1932 x 1932 pixels, FOV: 45 degrees
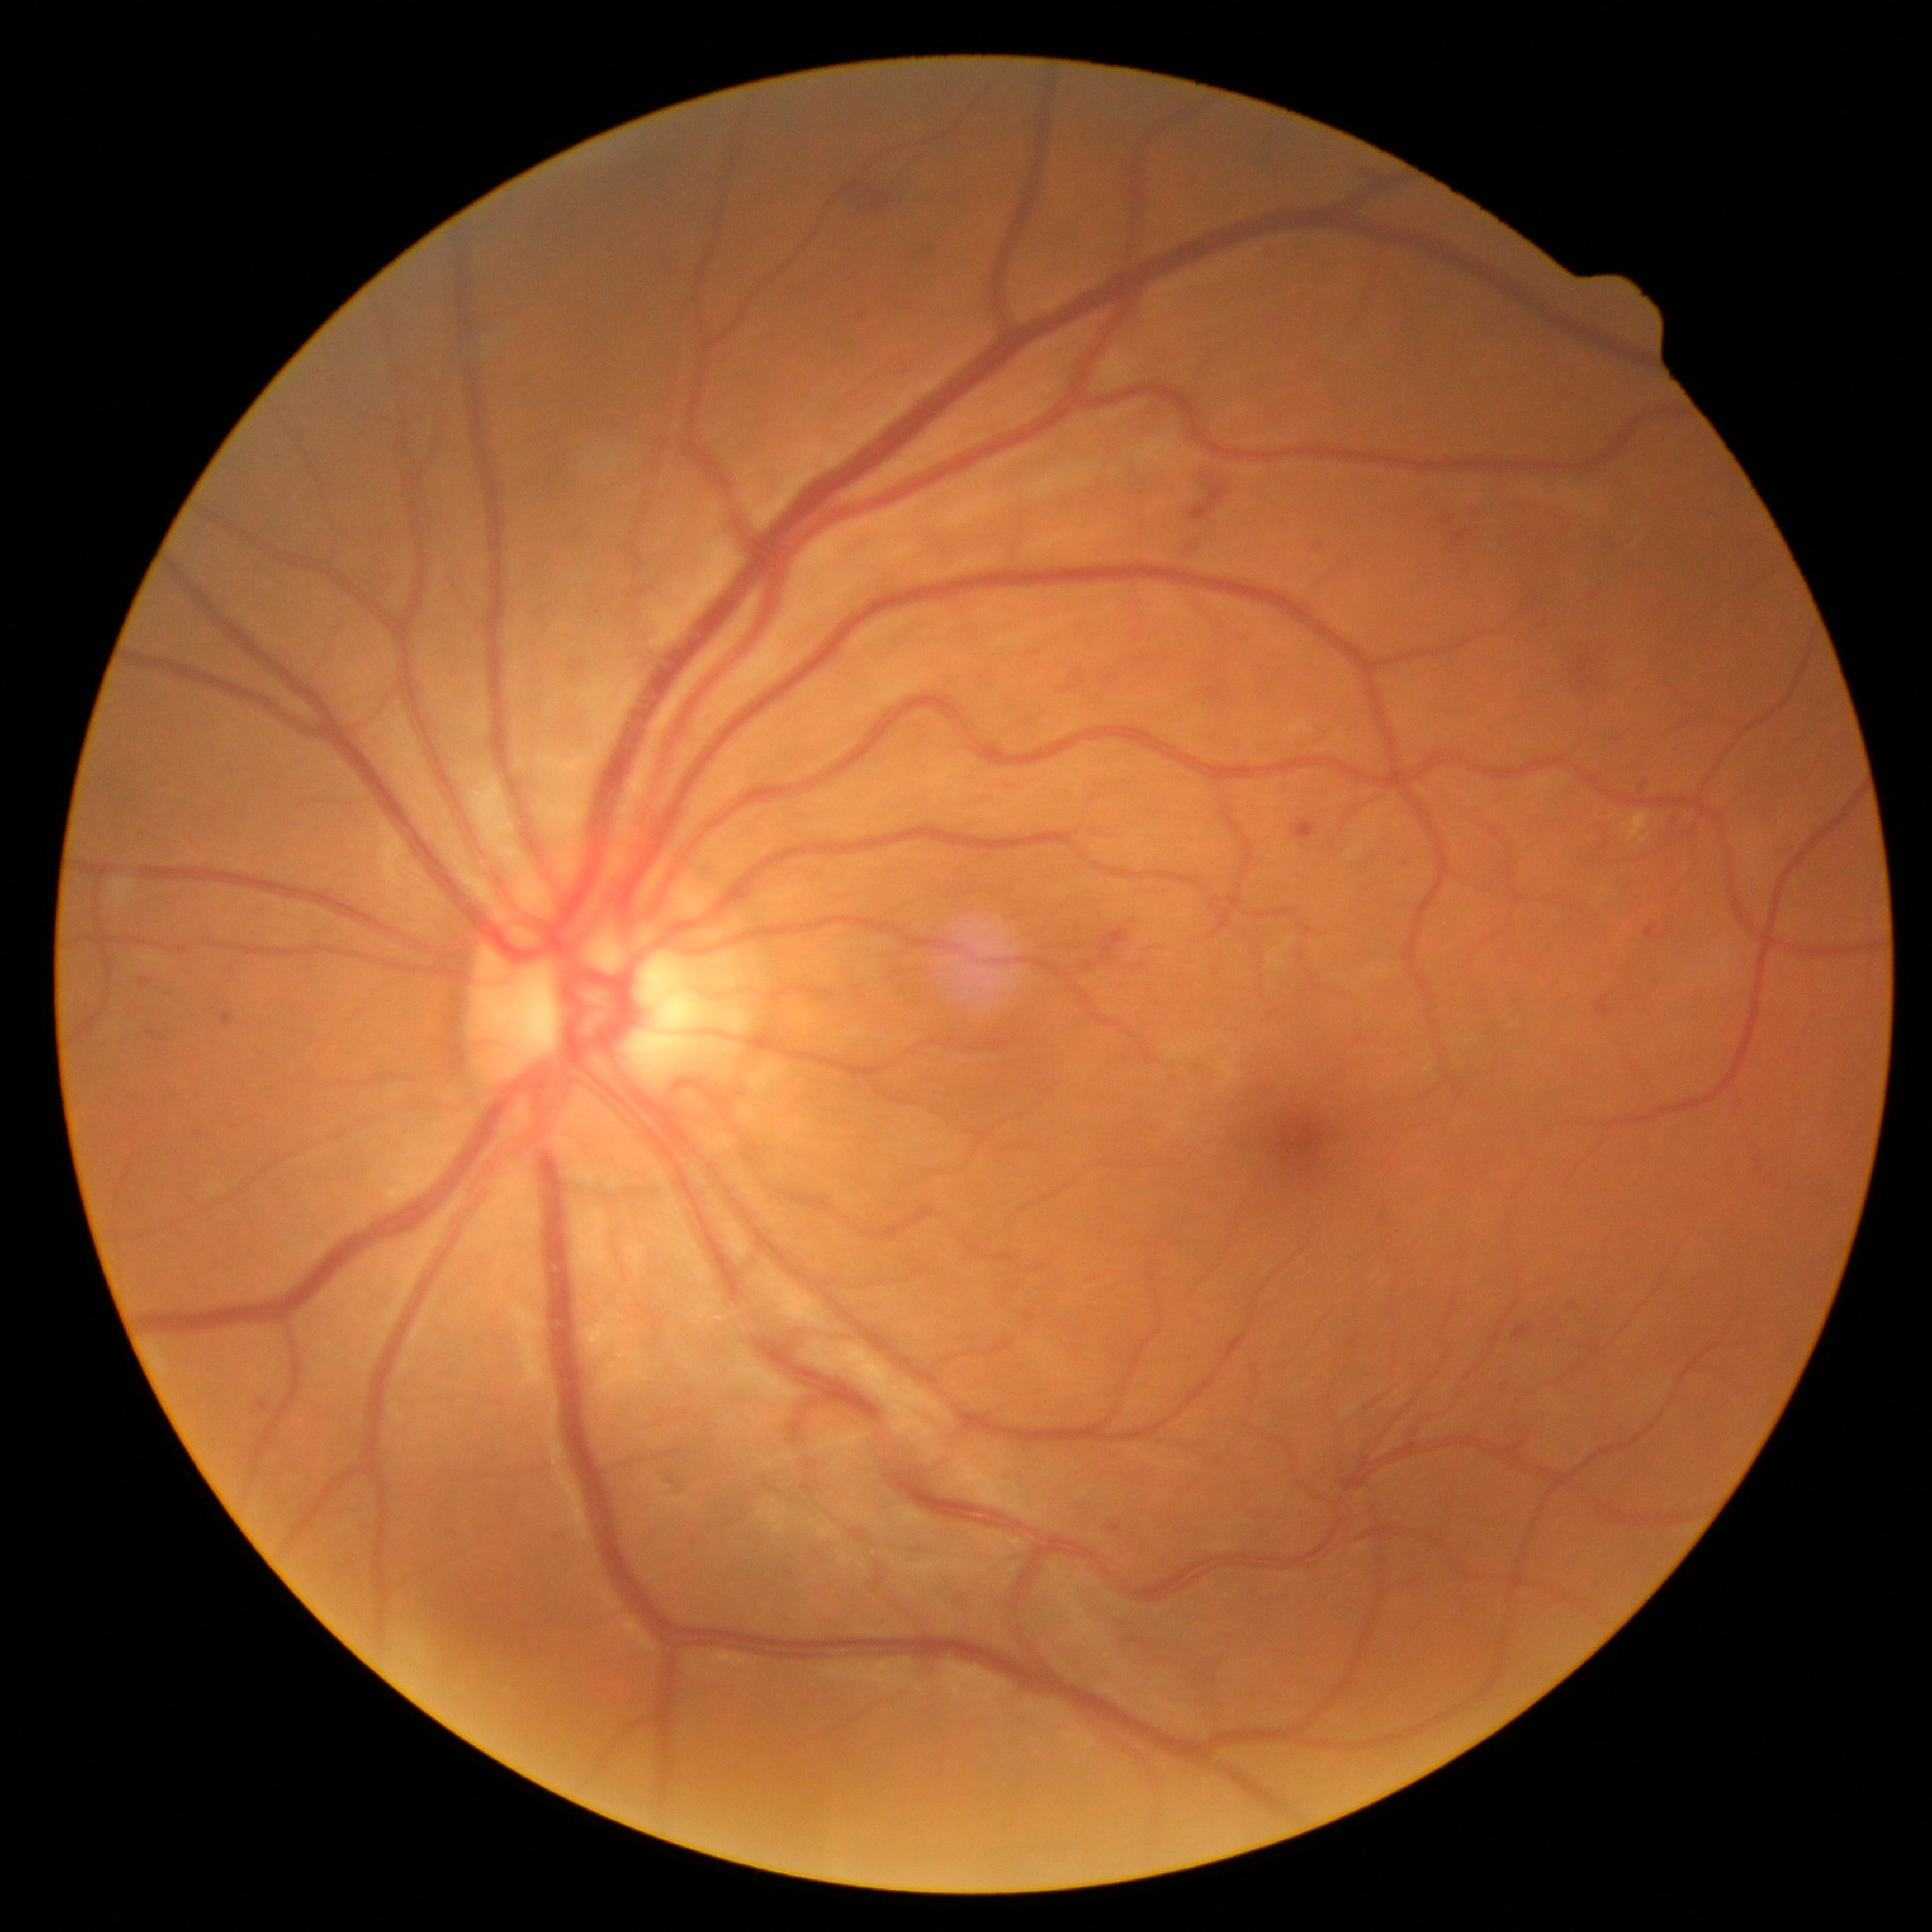

DR grade is 2 (moderate NPDR).
EXs identified at left=1641, top=835, right=1651, bottom=844, left=1627, top=811, right=1650, bottom=841.
No SEs identified.
MAs identified at left=1110, top=1524, right=1121, bottom=1532, left=1600, top=844, right=1609, bottom=853, left=146, top=1030, right=158, bottom=1039, left=222, top=1012, right=234, bottom=1027, left=1689, top=815, right=1701, bottom=827, left=259, top=1400, right=268, bottom=1412, left=1641, top=782, right=1650, bottom=793.
MAs (small, approximate centers) near (1619,741).
HEs identified at left=1292, top=820, right=1317, bottom=840, left=1597, top=995, right=1612, bottom=1018, left=1583, top=658, right=1588, bottom=675, left=847, top=173, right=908, bottom=217, left=1076, top=923, right=1130, bottom=977, left=924, top=247, right=935, bottom=254, left=1644, top=924, right=1656, bottom=941, left=1512, top=1325, right=1530, bottom=1341, left=1452, top=533, right=1464, bottom=548, left=1189, top=484, right=1227, bottom=522, left=1590, top=661, right=1599, bottom=673, left=1590, top=590, right=1603, bottom=599, left=1531, top=615, right=1552, bottom=637.
HEs (small, approximate centers) near (1584,684), (862,315), (1449,521).